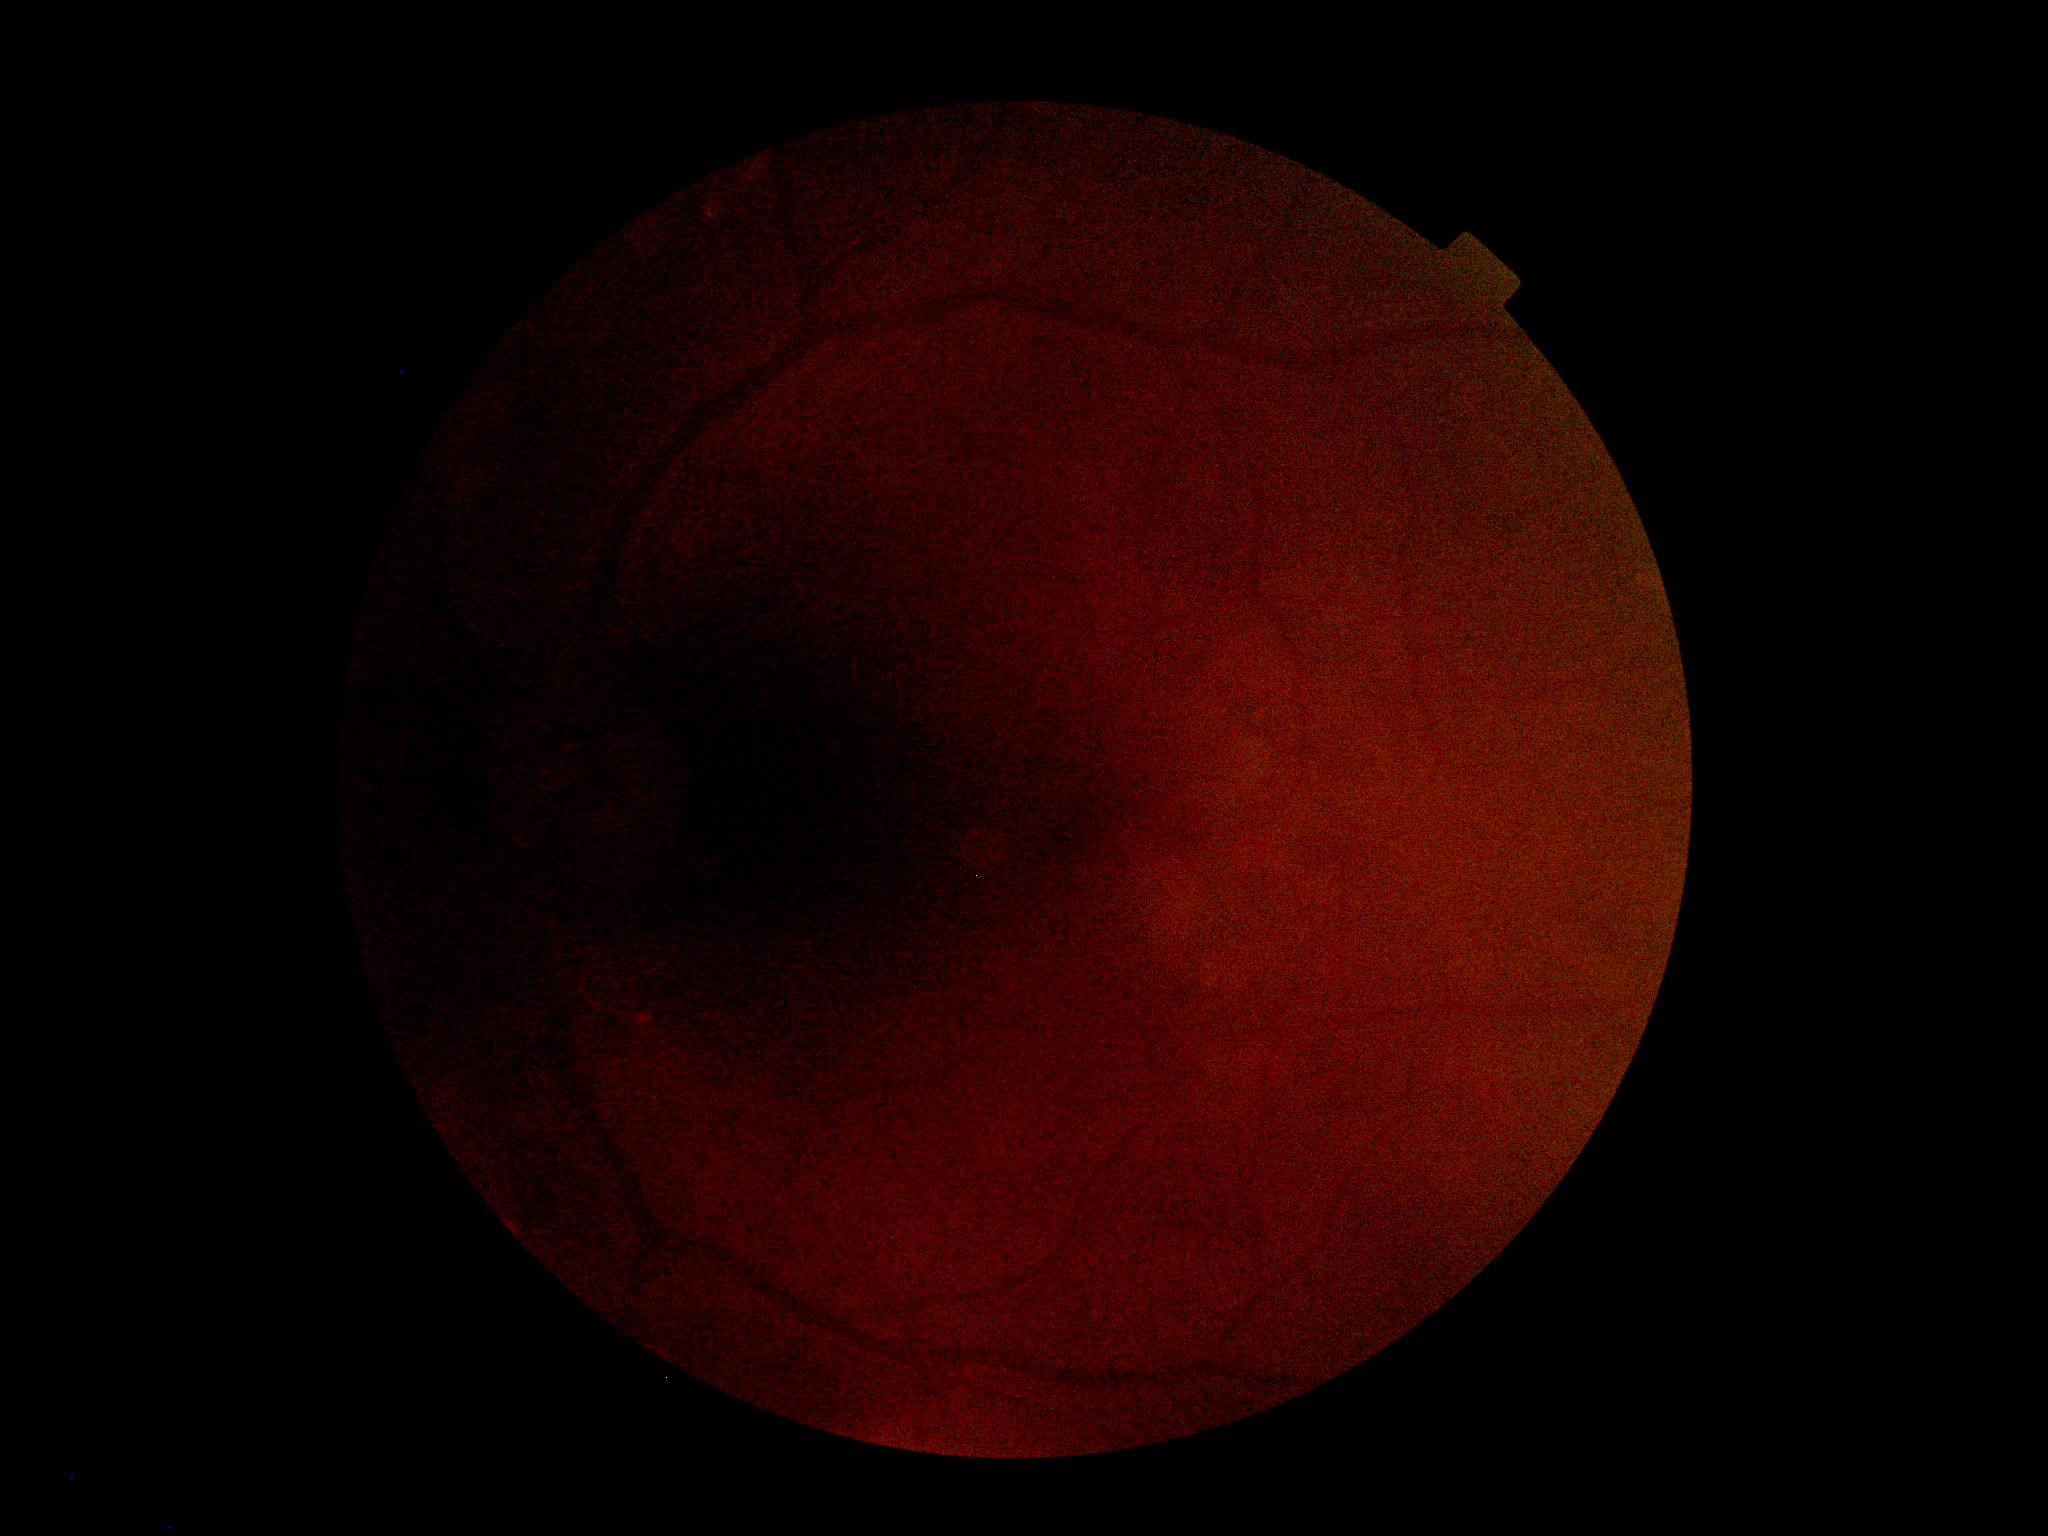
Retinopathy is ungradable.